640x480px; wide-field contact fundus photograph of an infant.
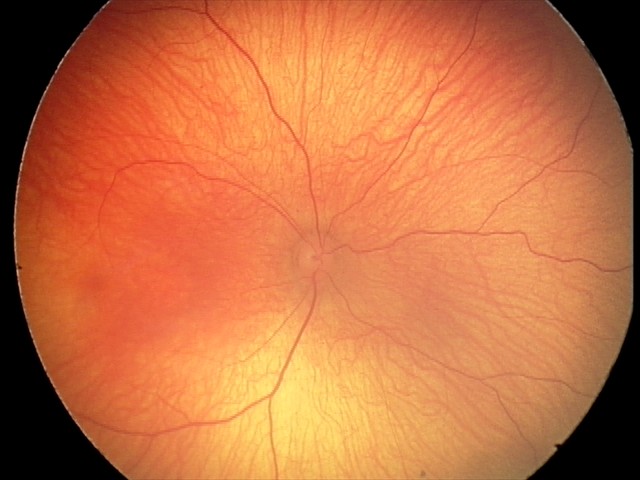 Q: What is the diagnosis from this examination?
A: normal retinal appearance